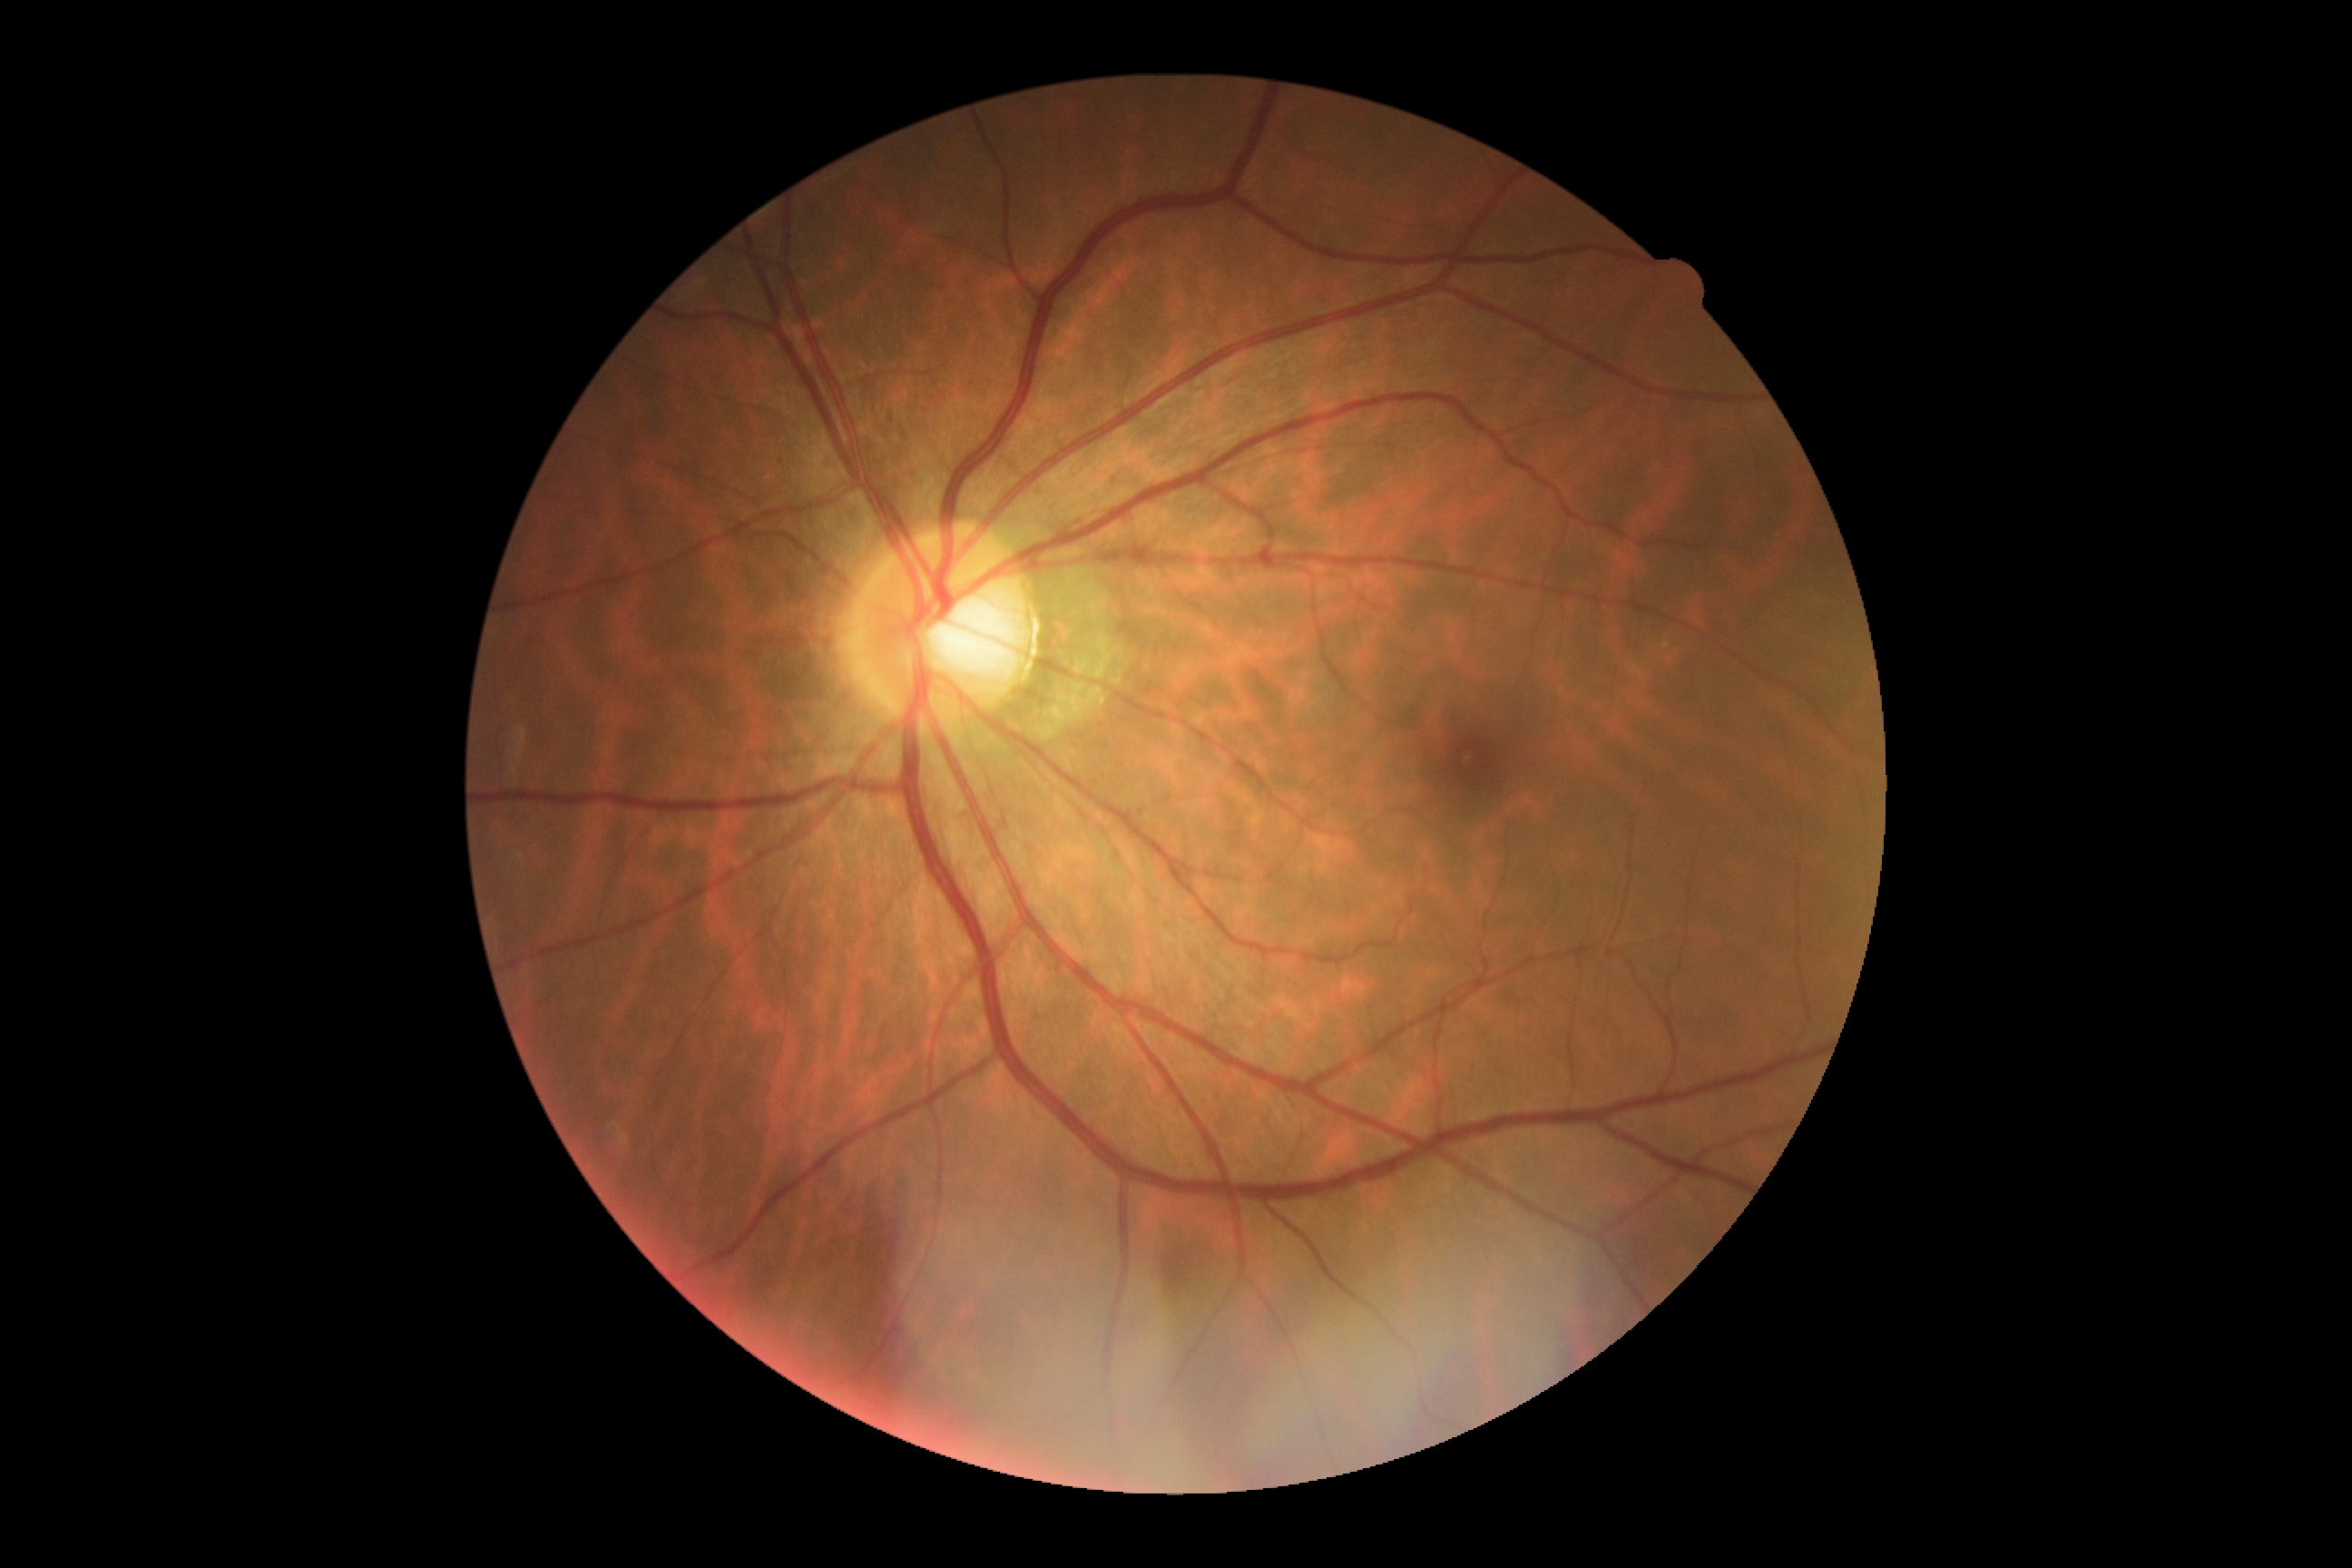 Diabetic retinopathy grade: no apparent diabetic retinopathy (0).